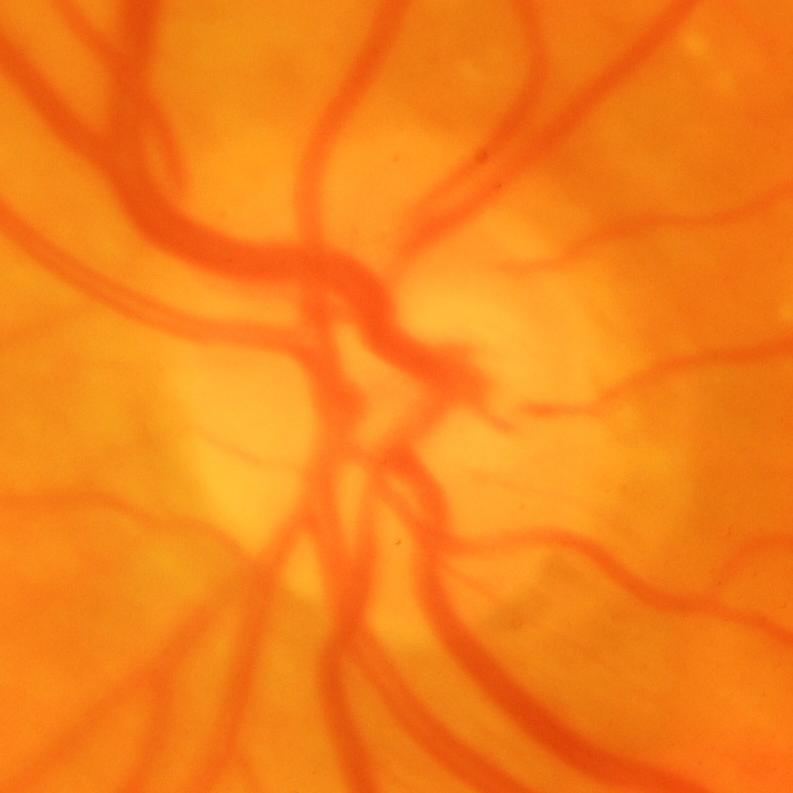
Q: What is the glaucoma diagnosis?
A: Yes — glaucomatous changes.